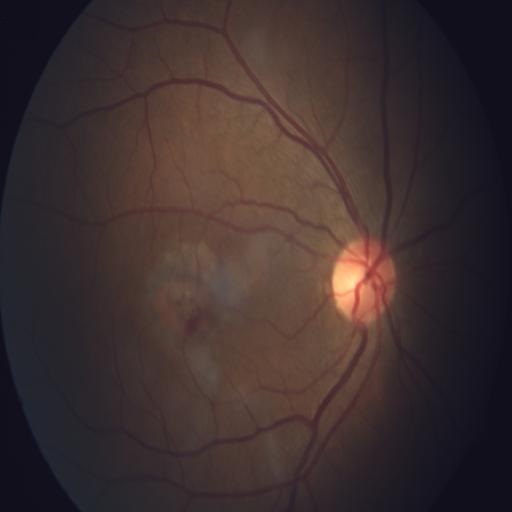

This fundus photograph shows macular scar.